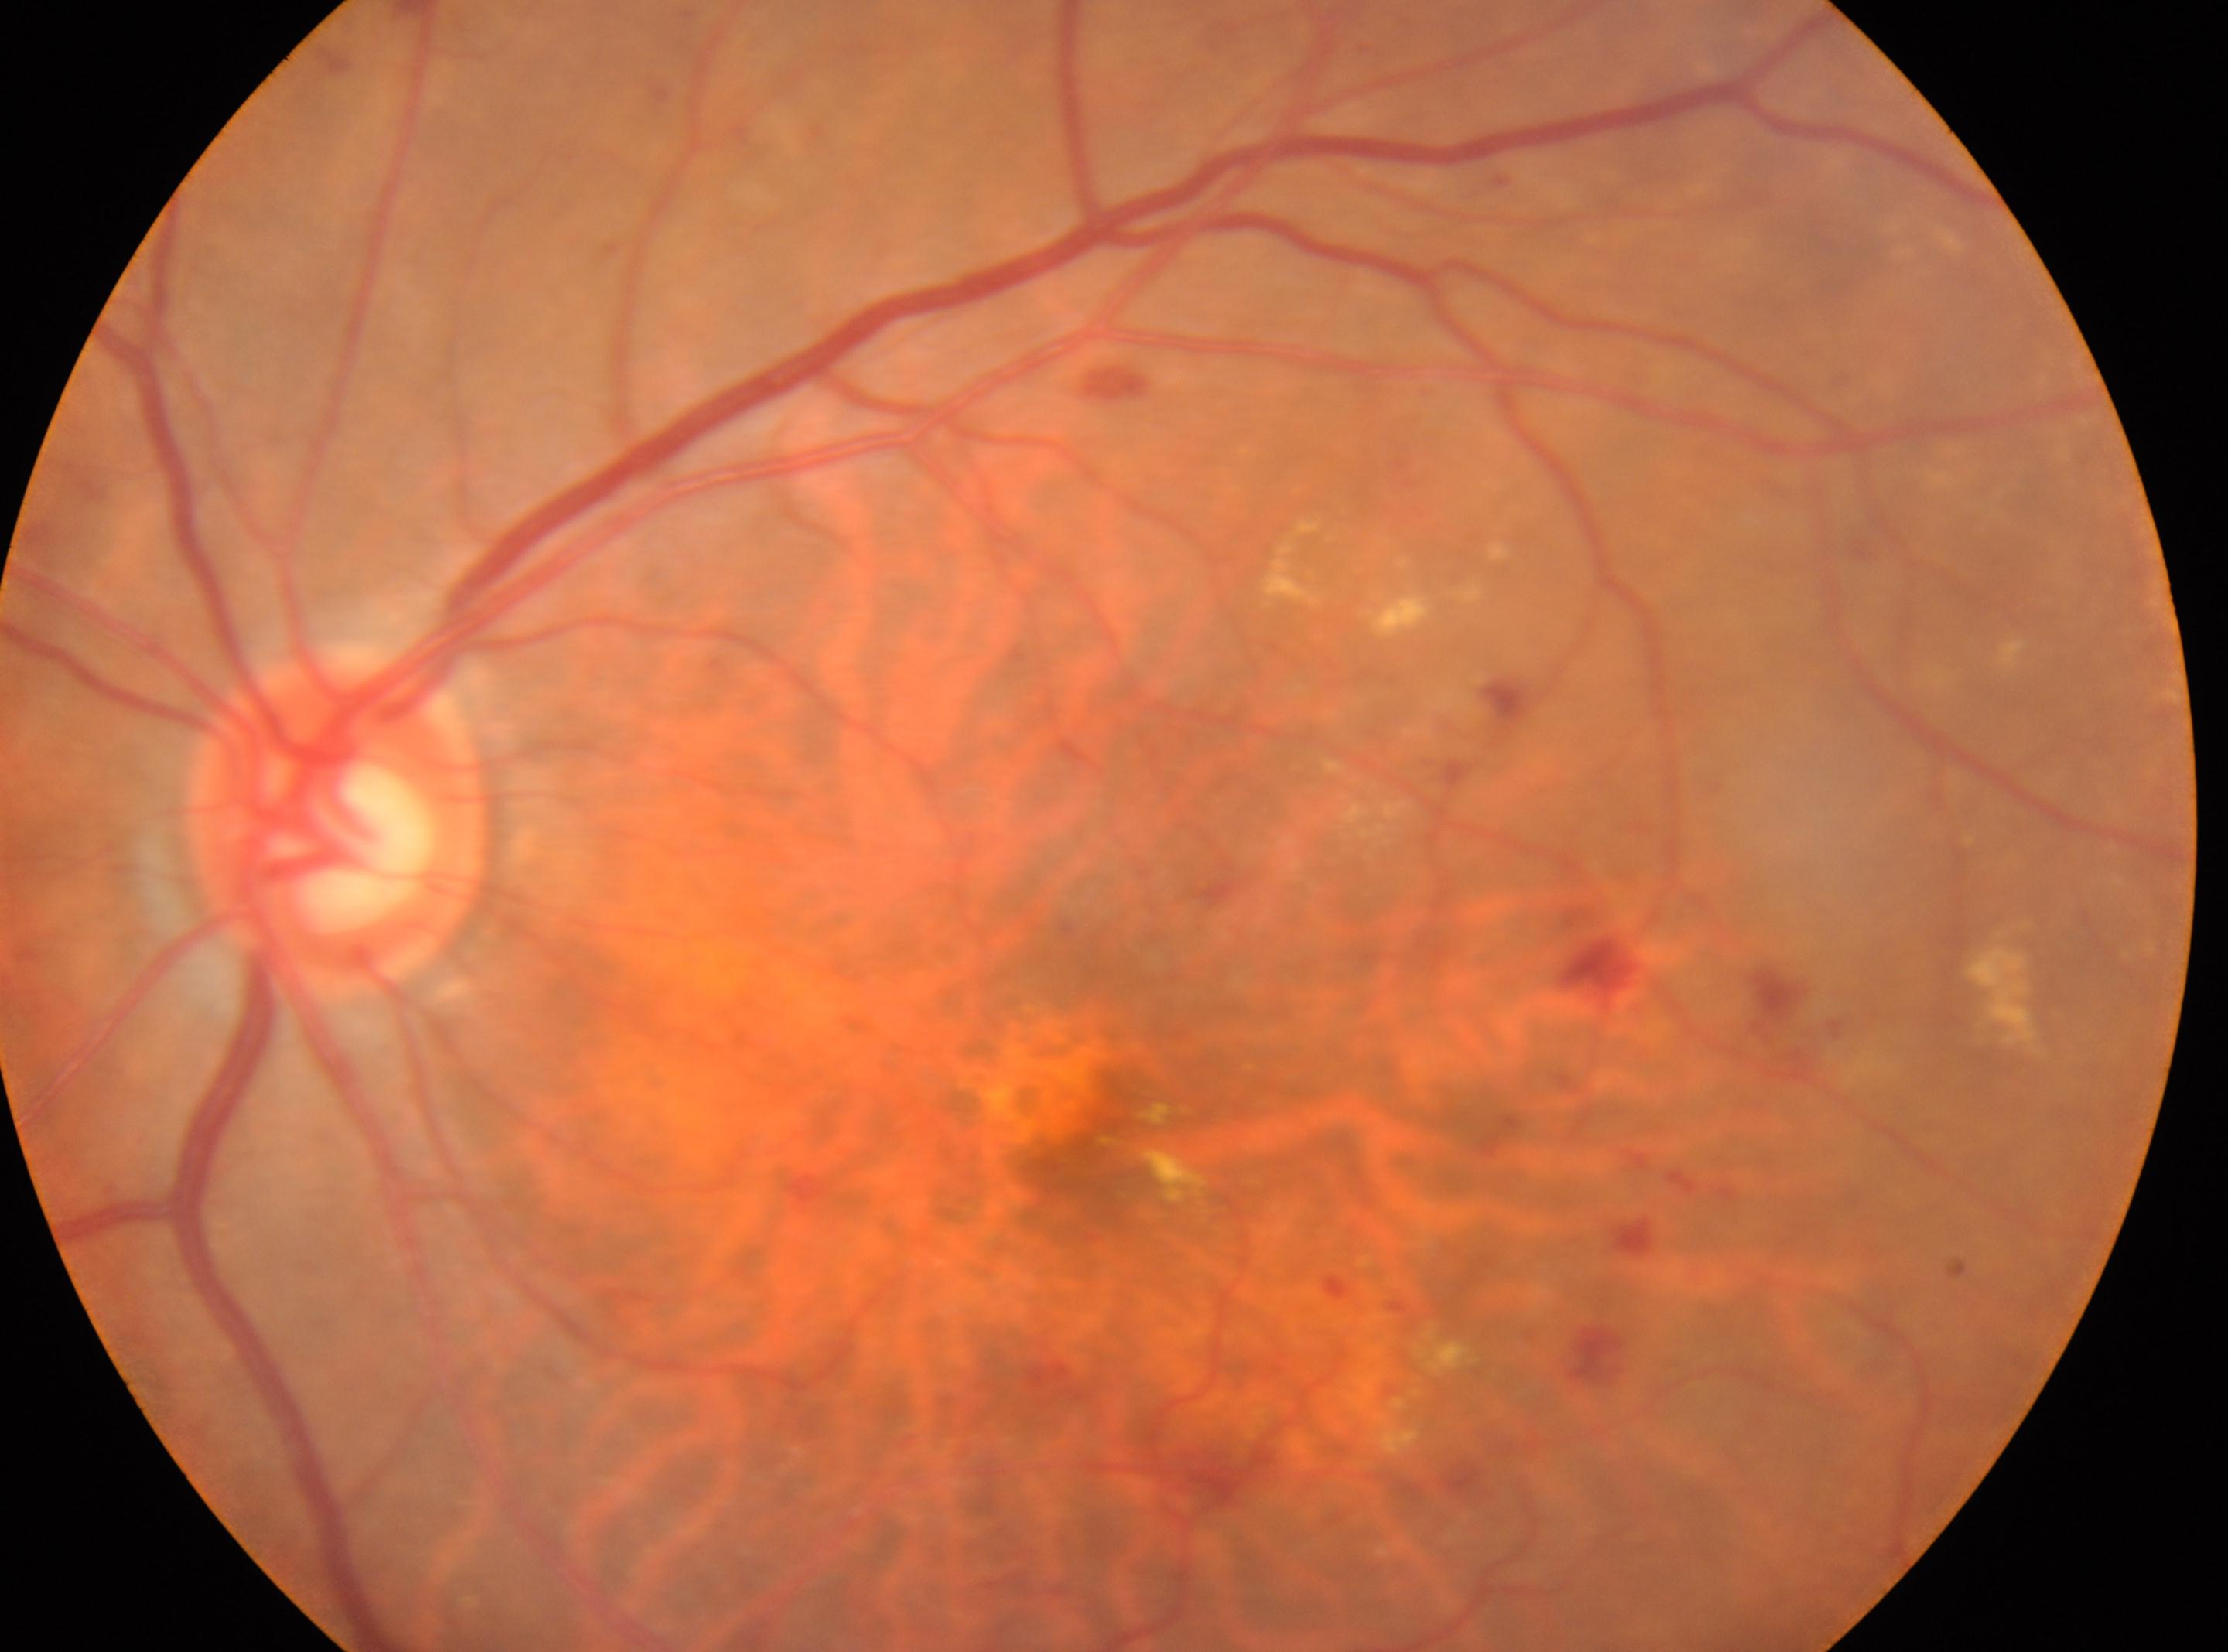
The fovea is at (x: 1082, y: 1138). This is the left eye. DR severity is 2. The disc center is at (x: 336, y: 821).